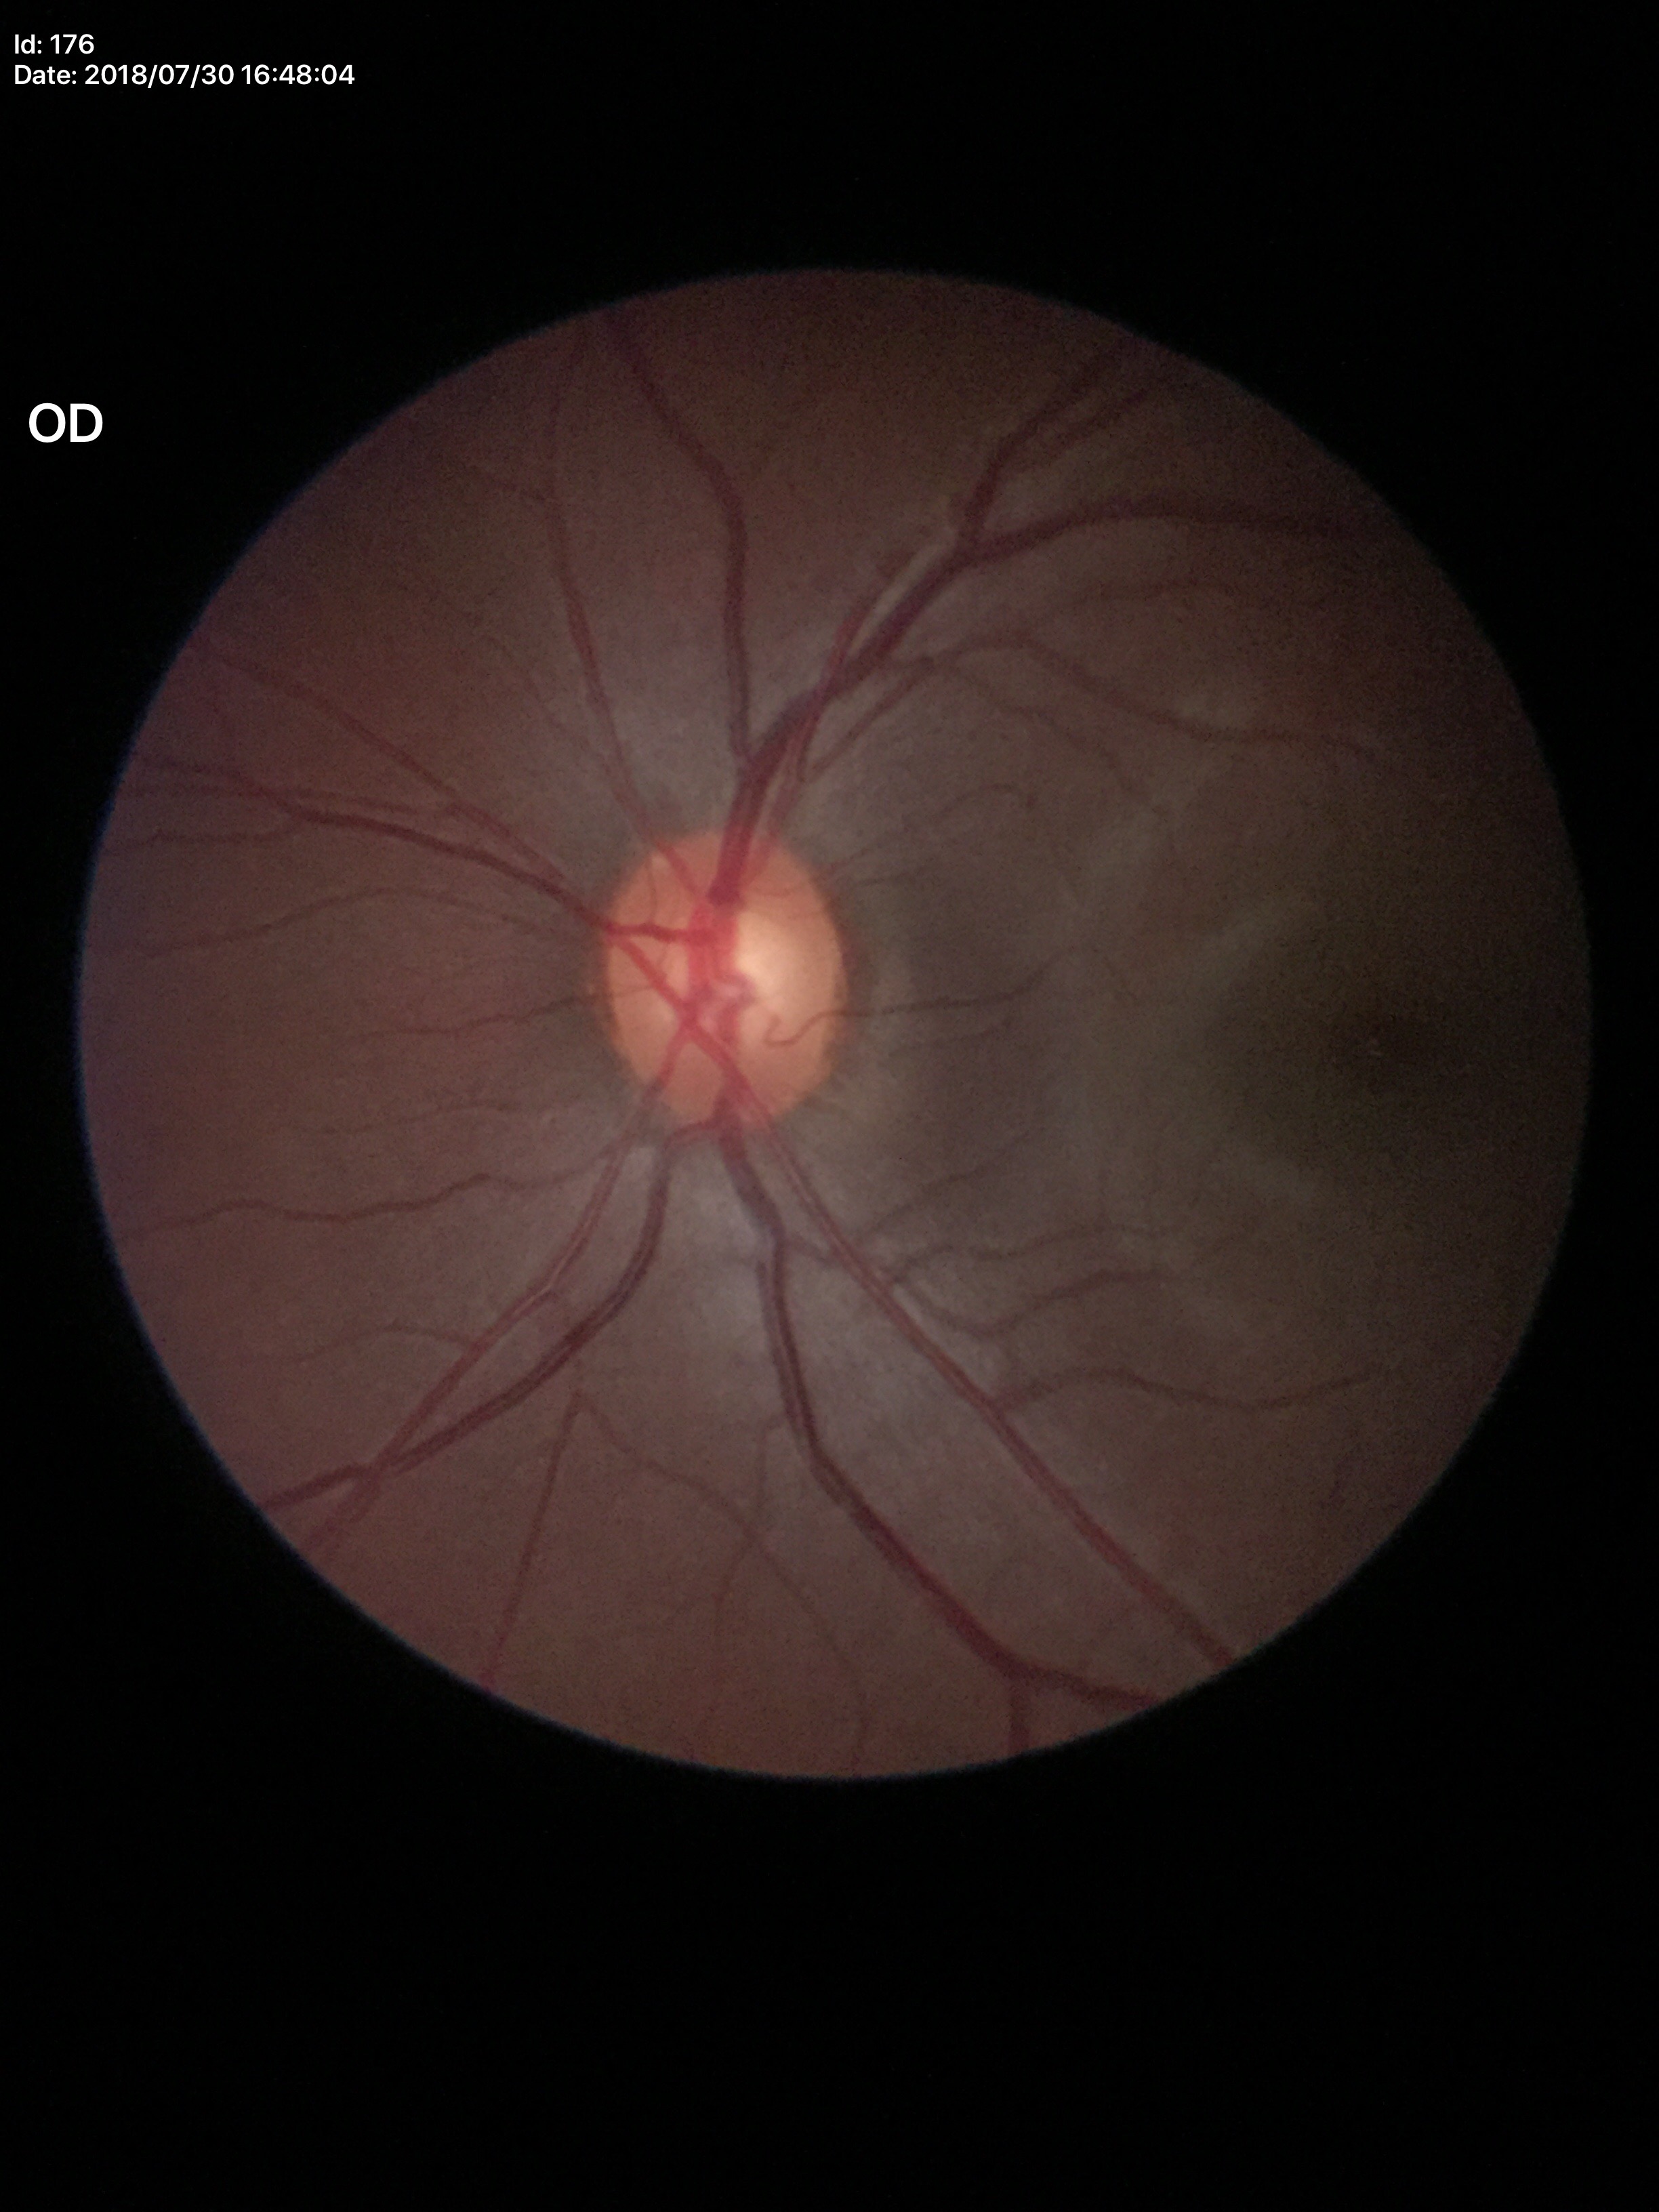

Glaucoma decision: not suspect (two of five ophthalmologists flagged glaucoma suspect). Horizontal cup-disc ratio of 0.59. Vertical C/D ratio of 0.56.